Posterior pole field covering the optic disc and macula — 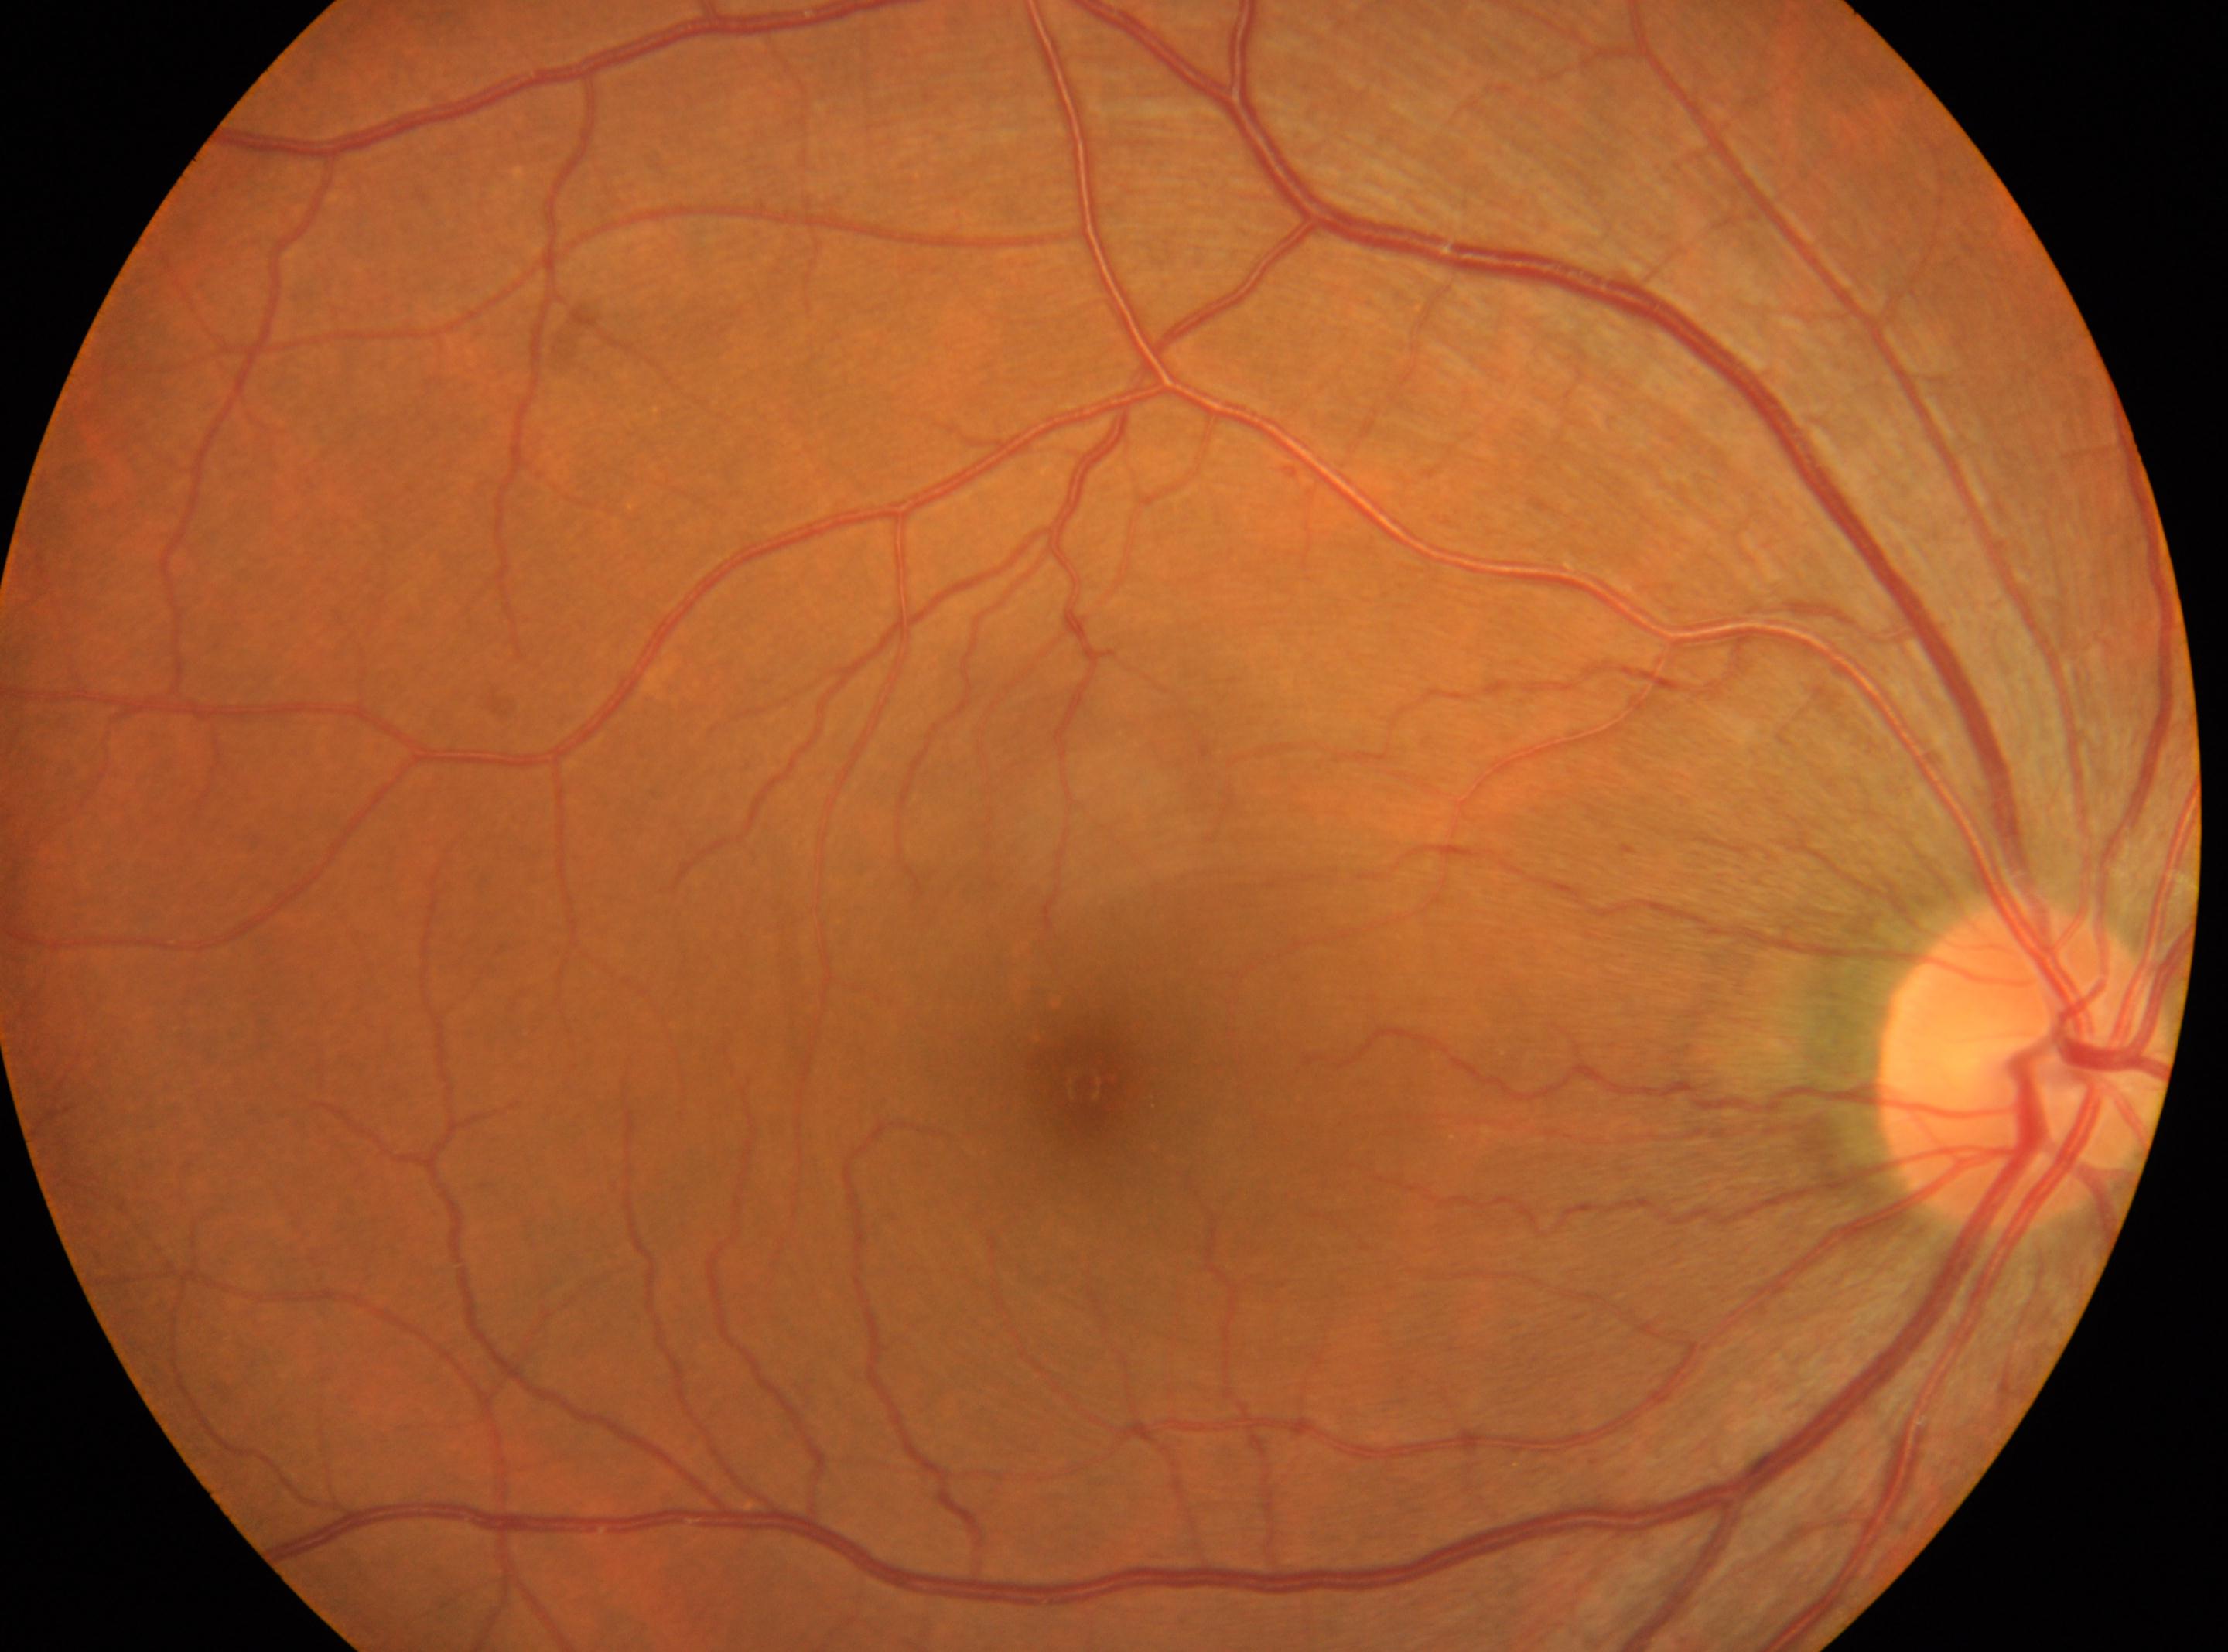 Eye: right.
Foveal center located at x=1082, y=1084.
Optic disc center: x=2027, y=1062.
Diabetic retinopathy (DR): grade 0.